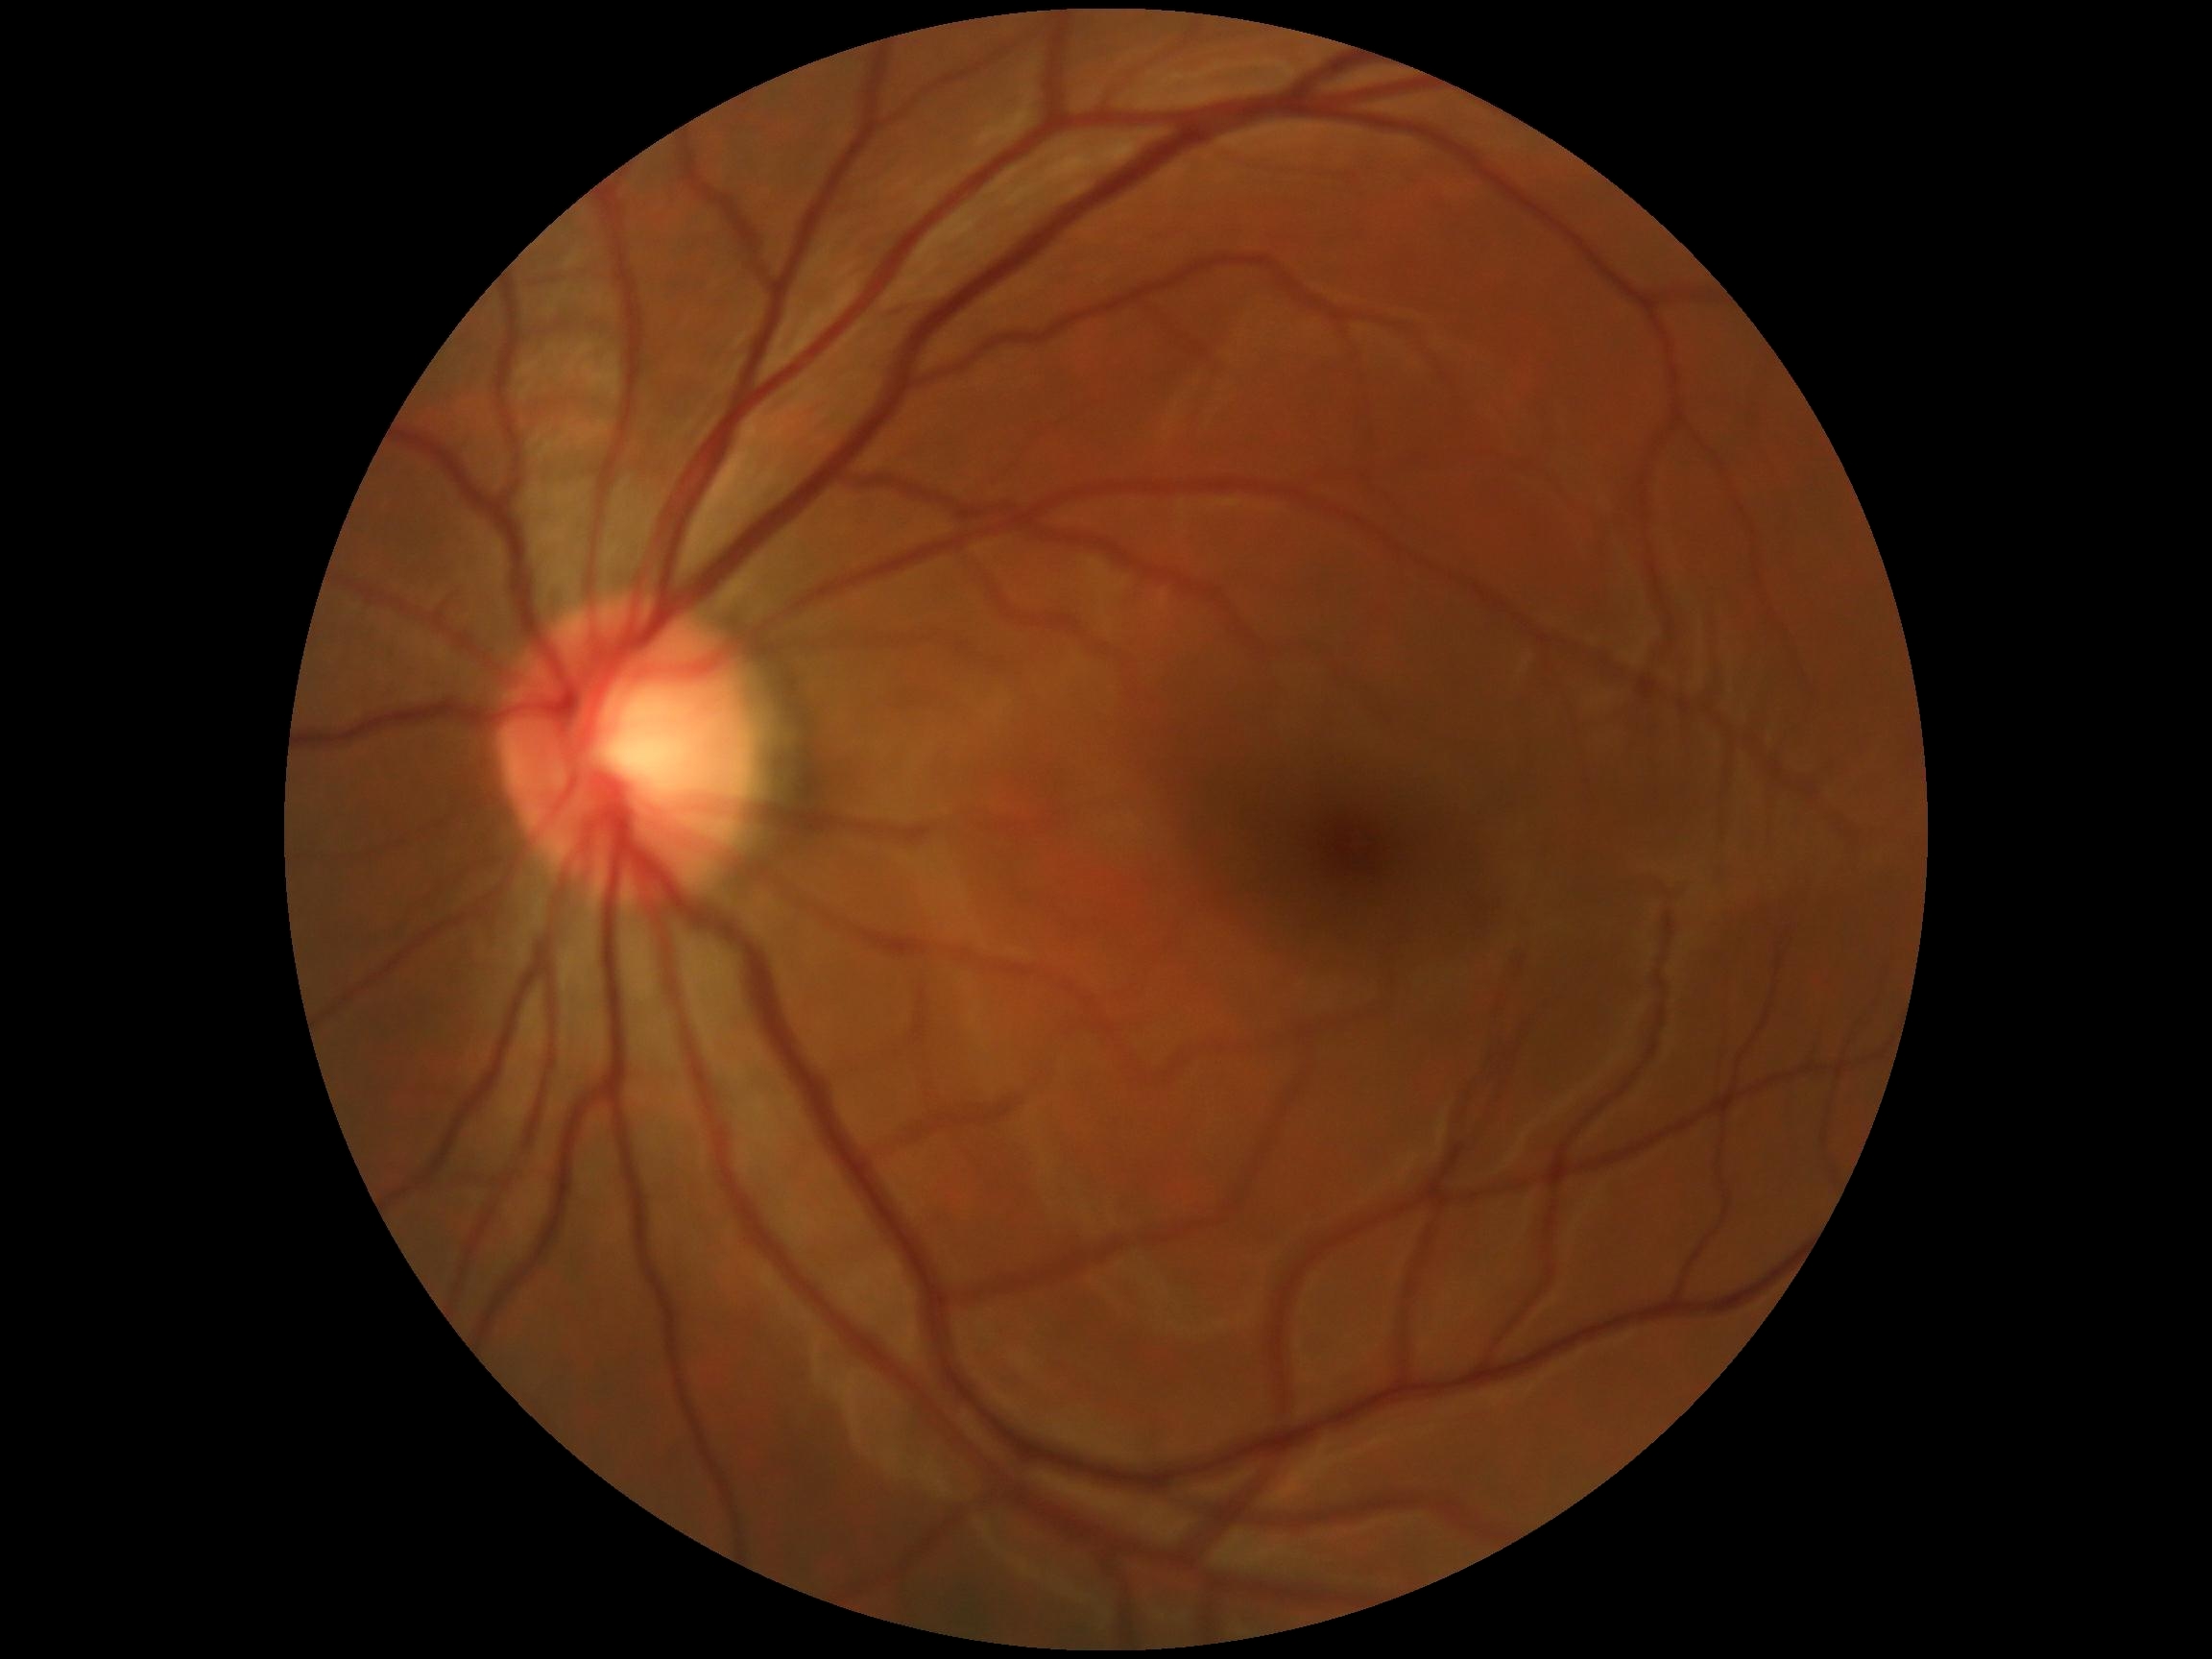 retinopathy: 0/4; DR impression: no signs of DR.